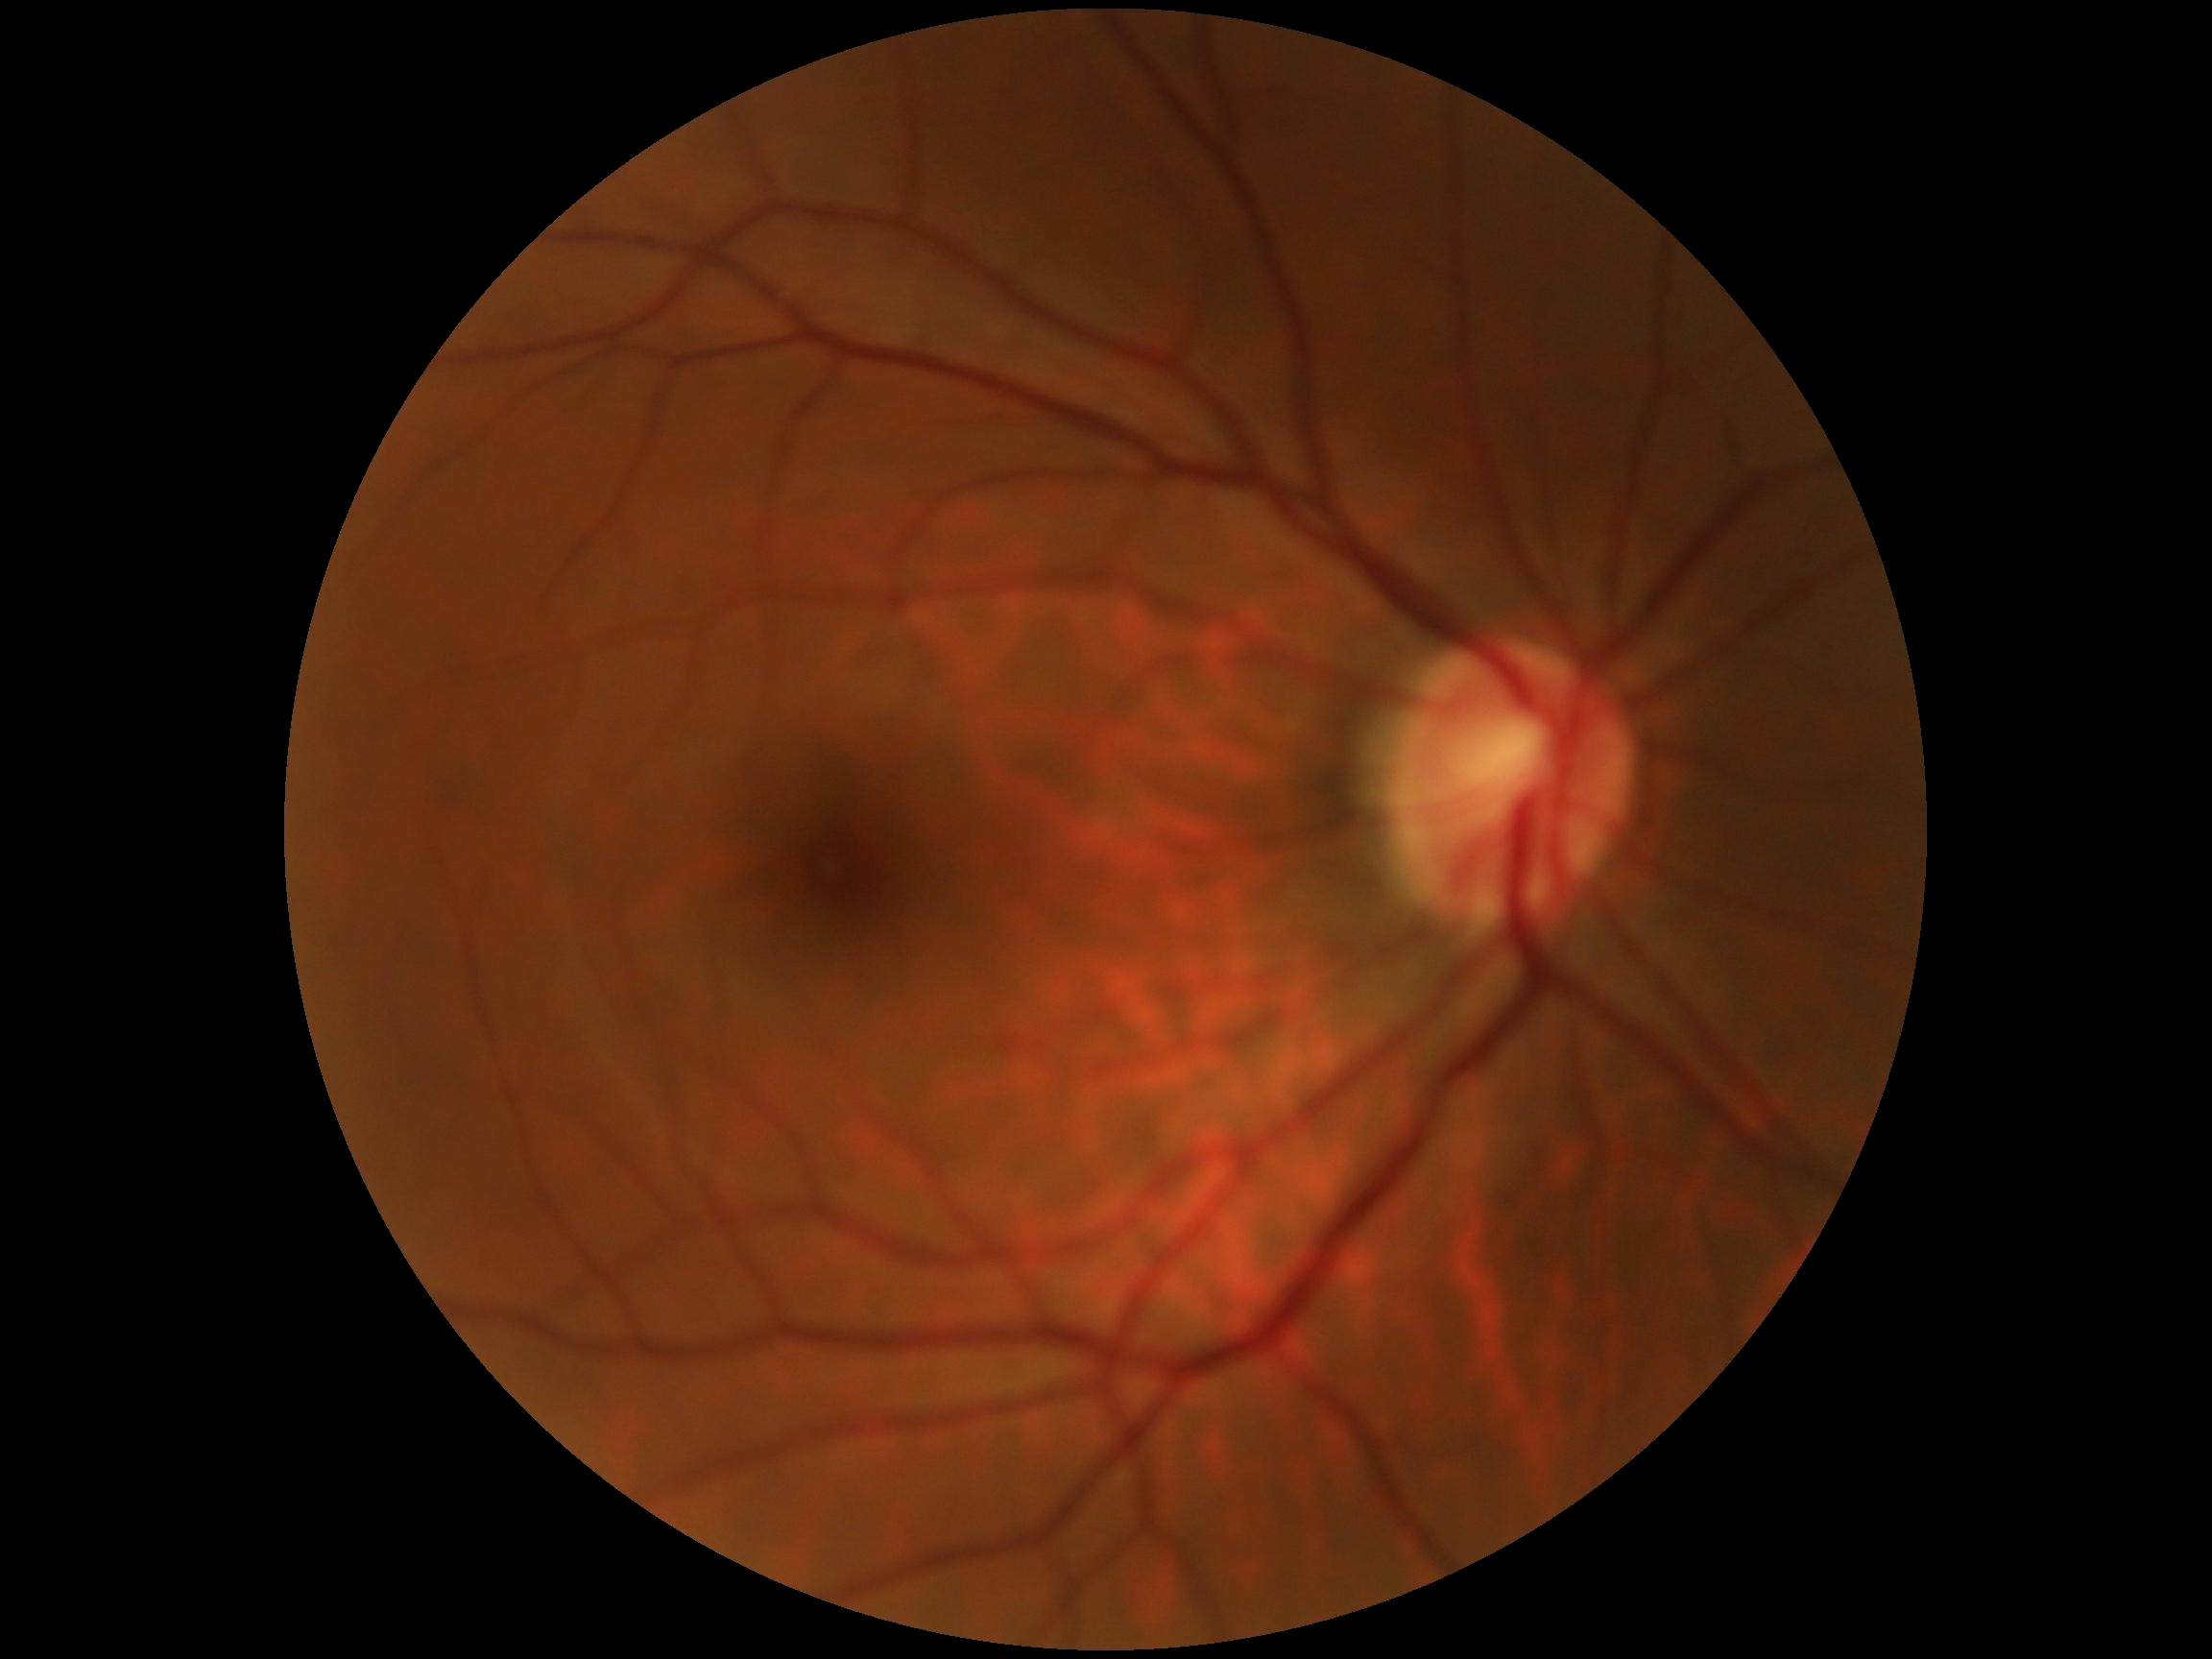
DR stage is 0/4.
No apparent diabetic retinopathy.